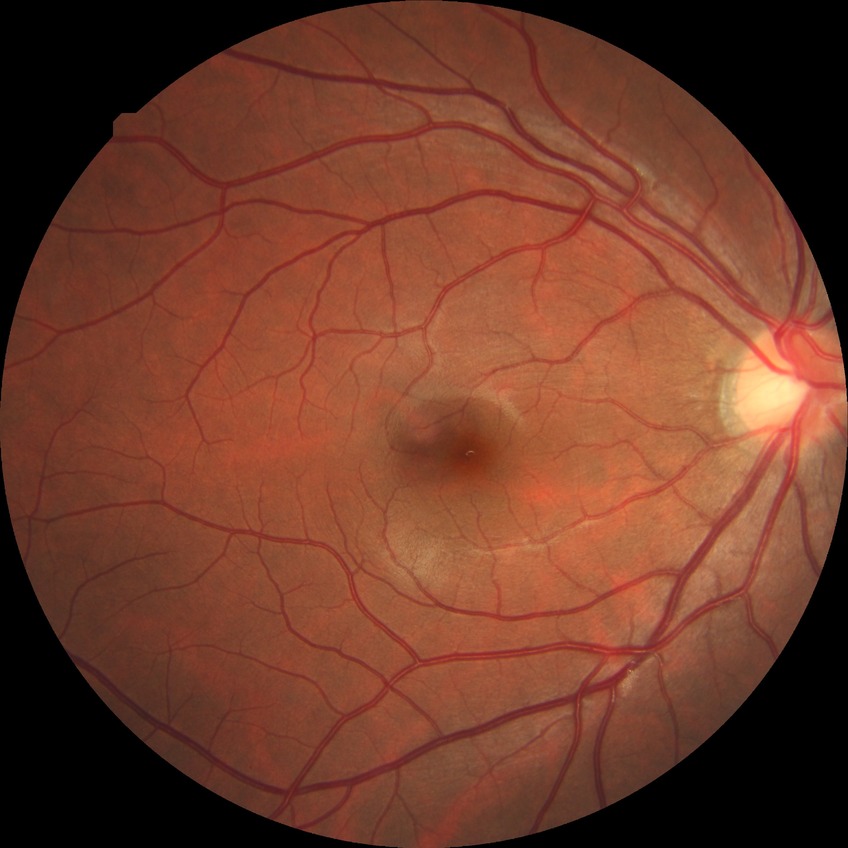
Diabetic retinopathy severity is no diabetic retinopathy.